Modified Davis grading: 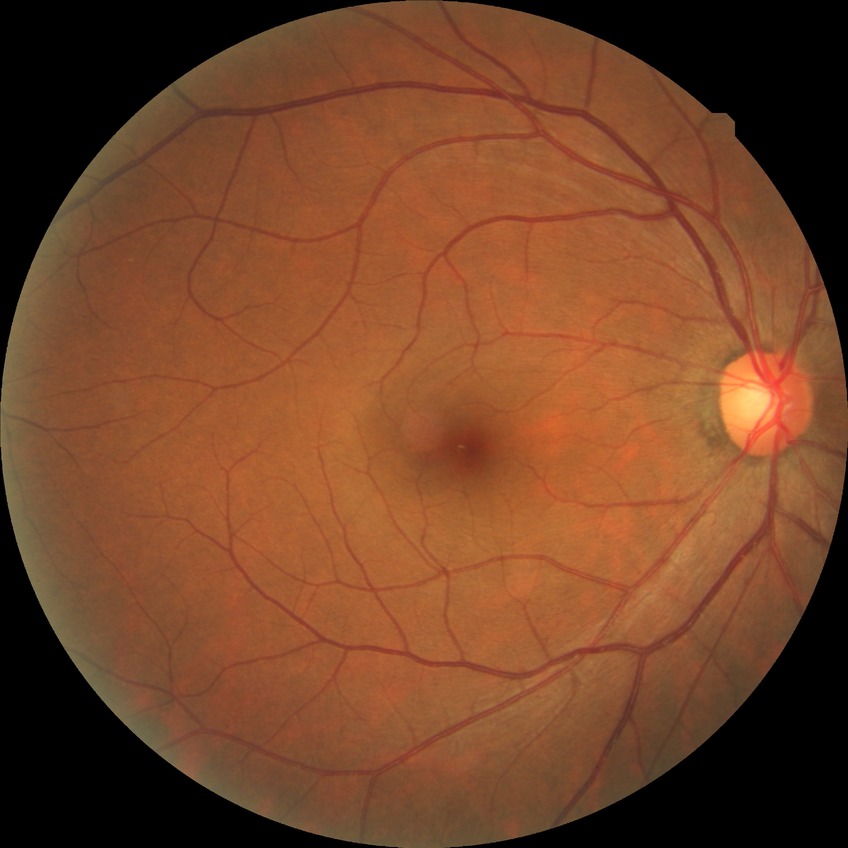
  davis_grade: NDR (no diabetic retinopathy)